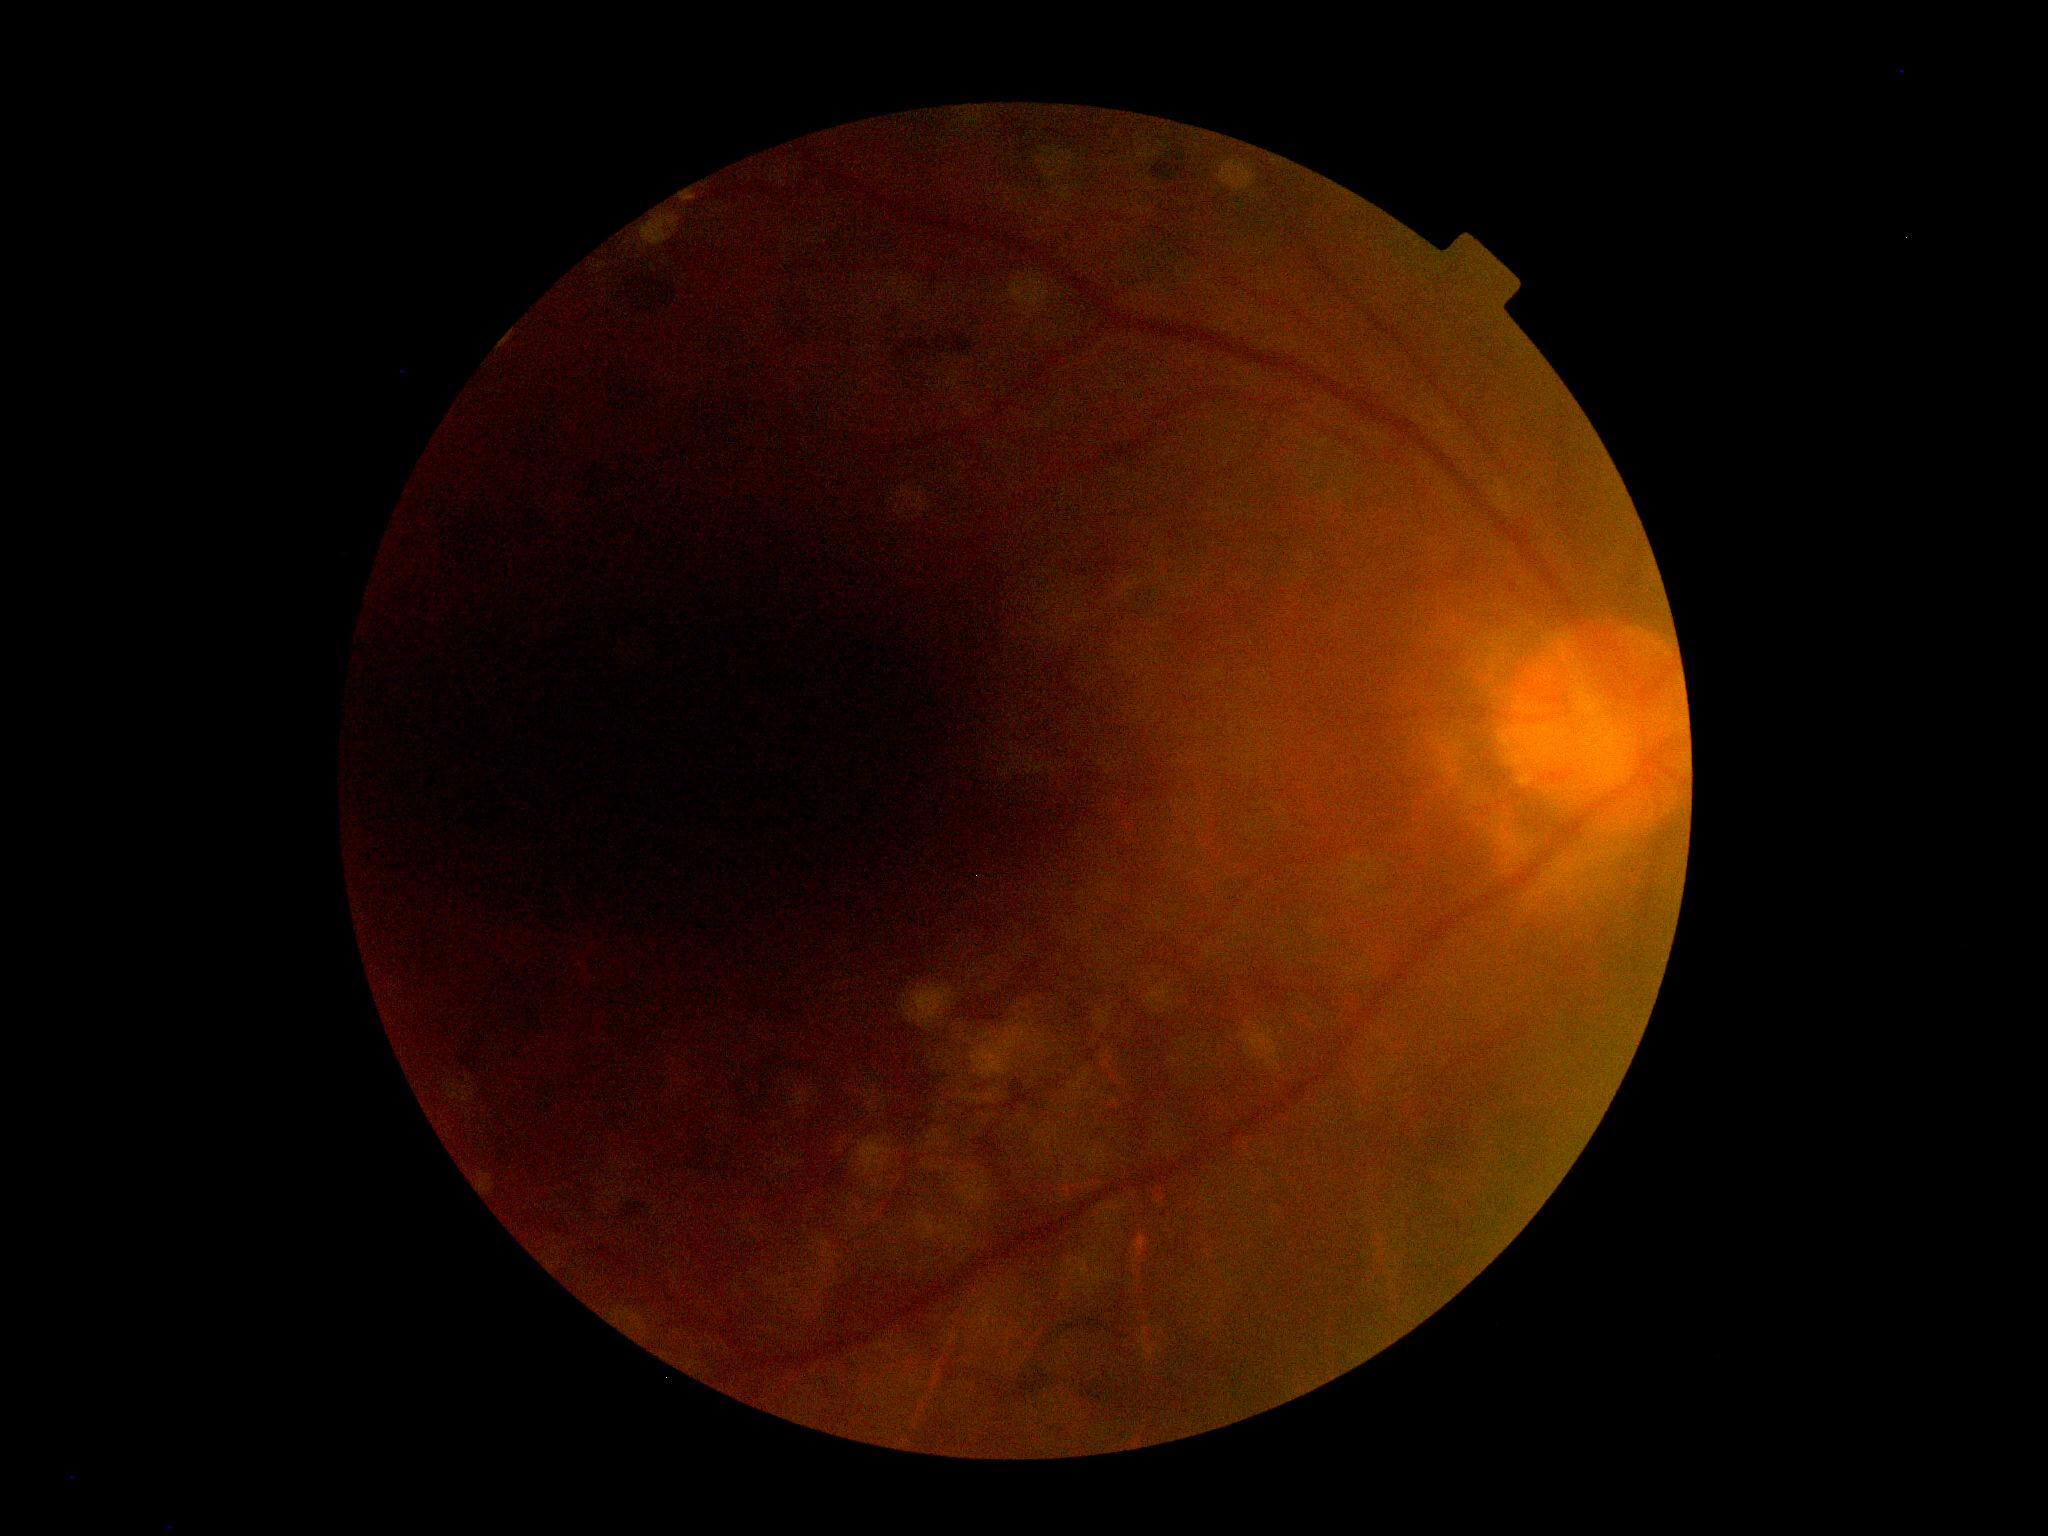 DR severity: ungradable. The image cannot be graded for diabetic retinopathy.